848x848 · color fundus photograph · no pharmacologic dilation · camera: NIDEK AFC-230
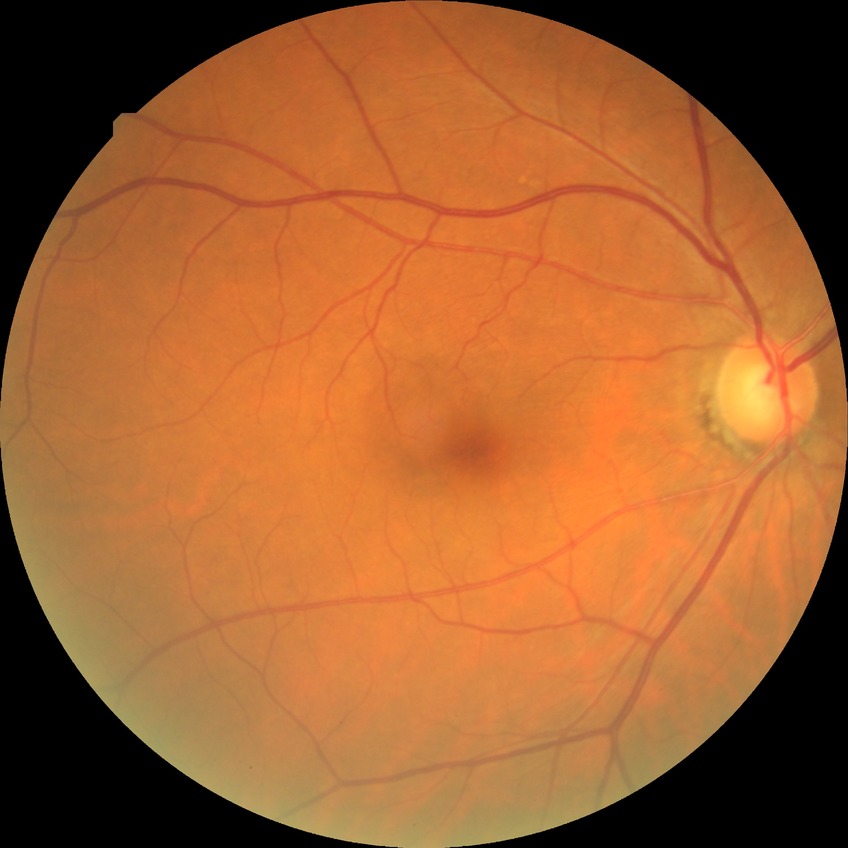 Modified Davis grade is NDR. No signs of diabetic retinopathy.